2212 x 1659 pixels: 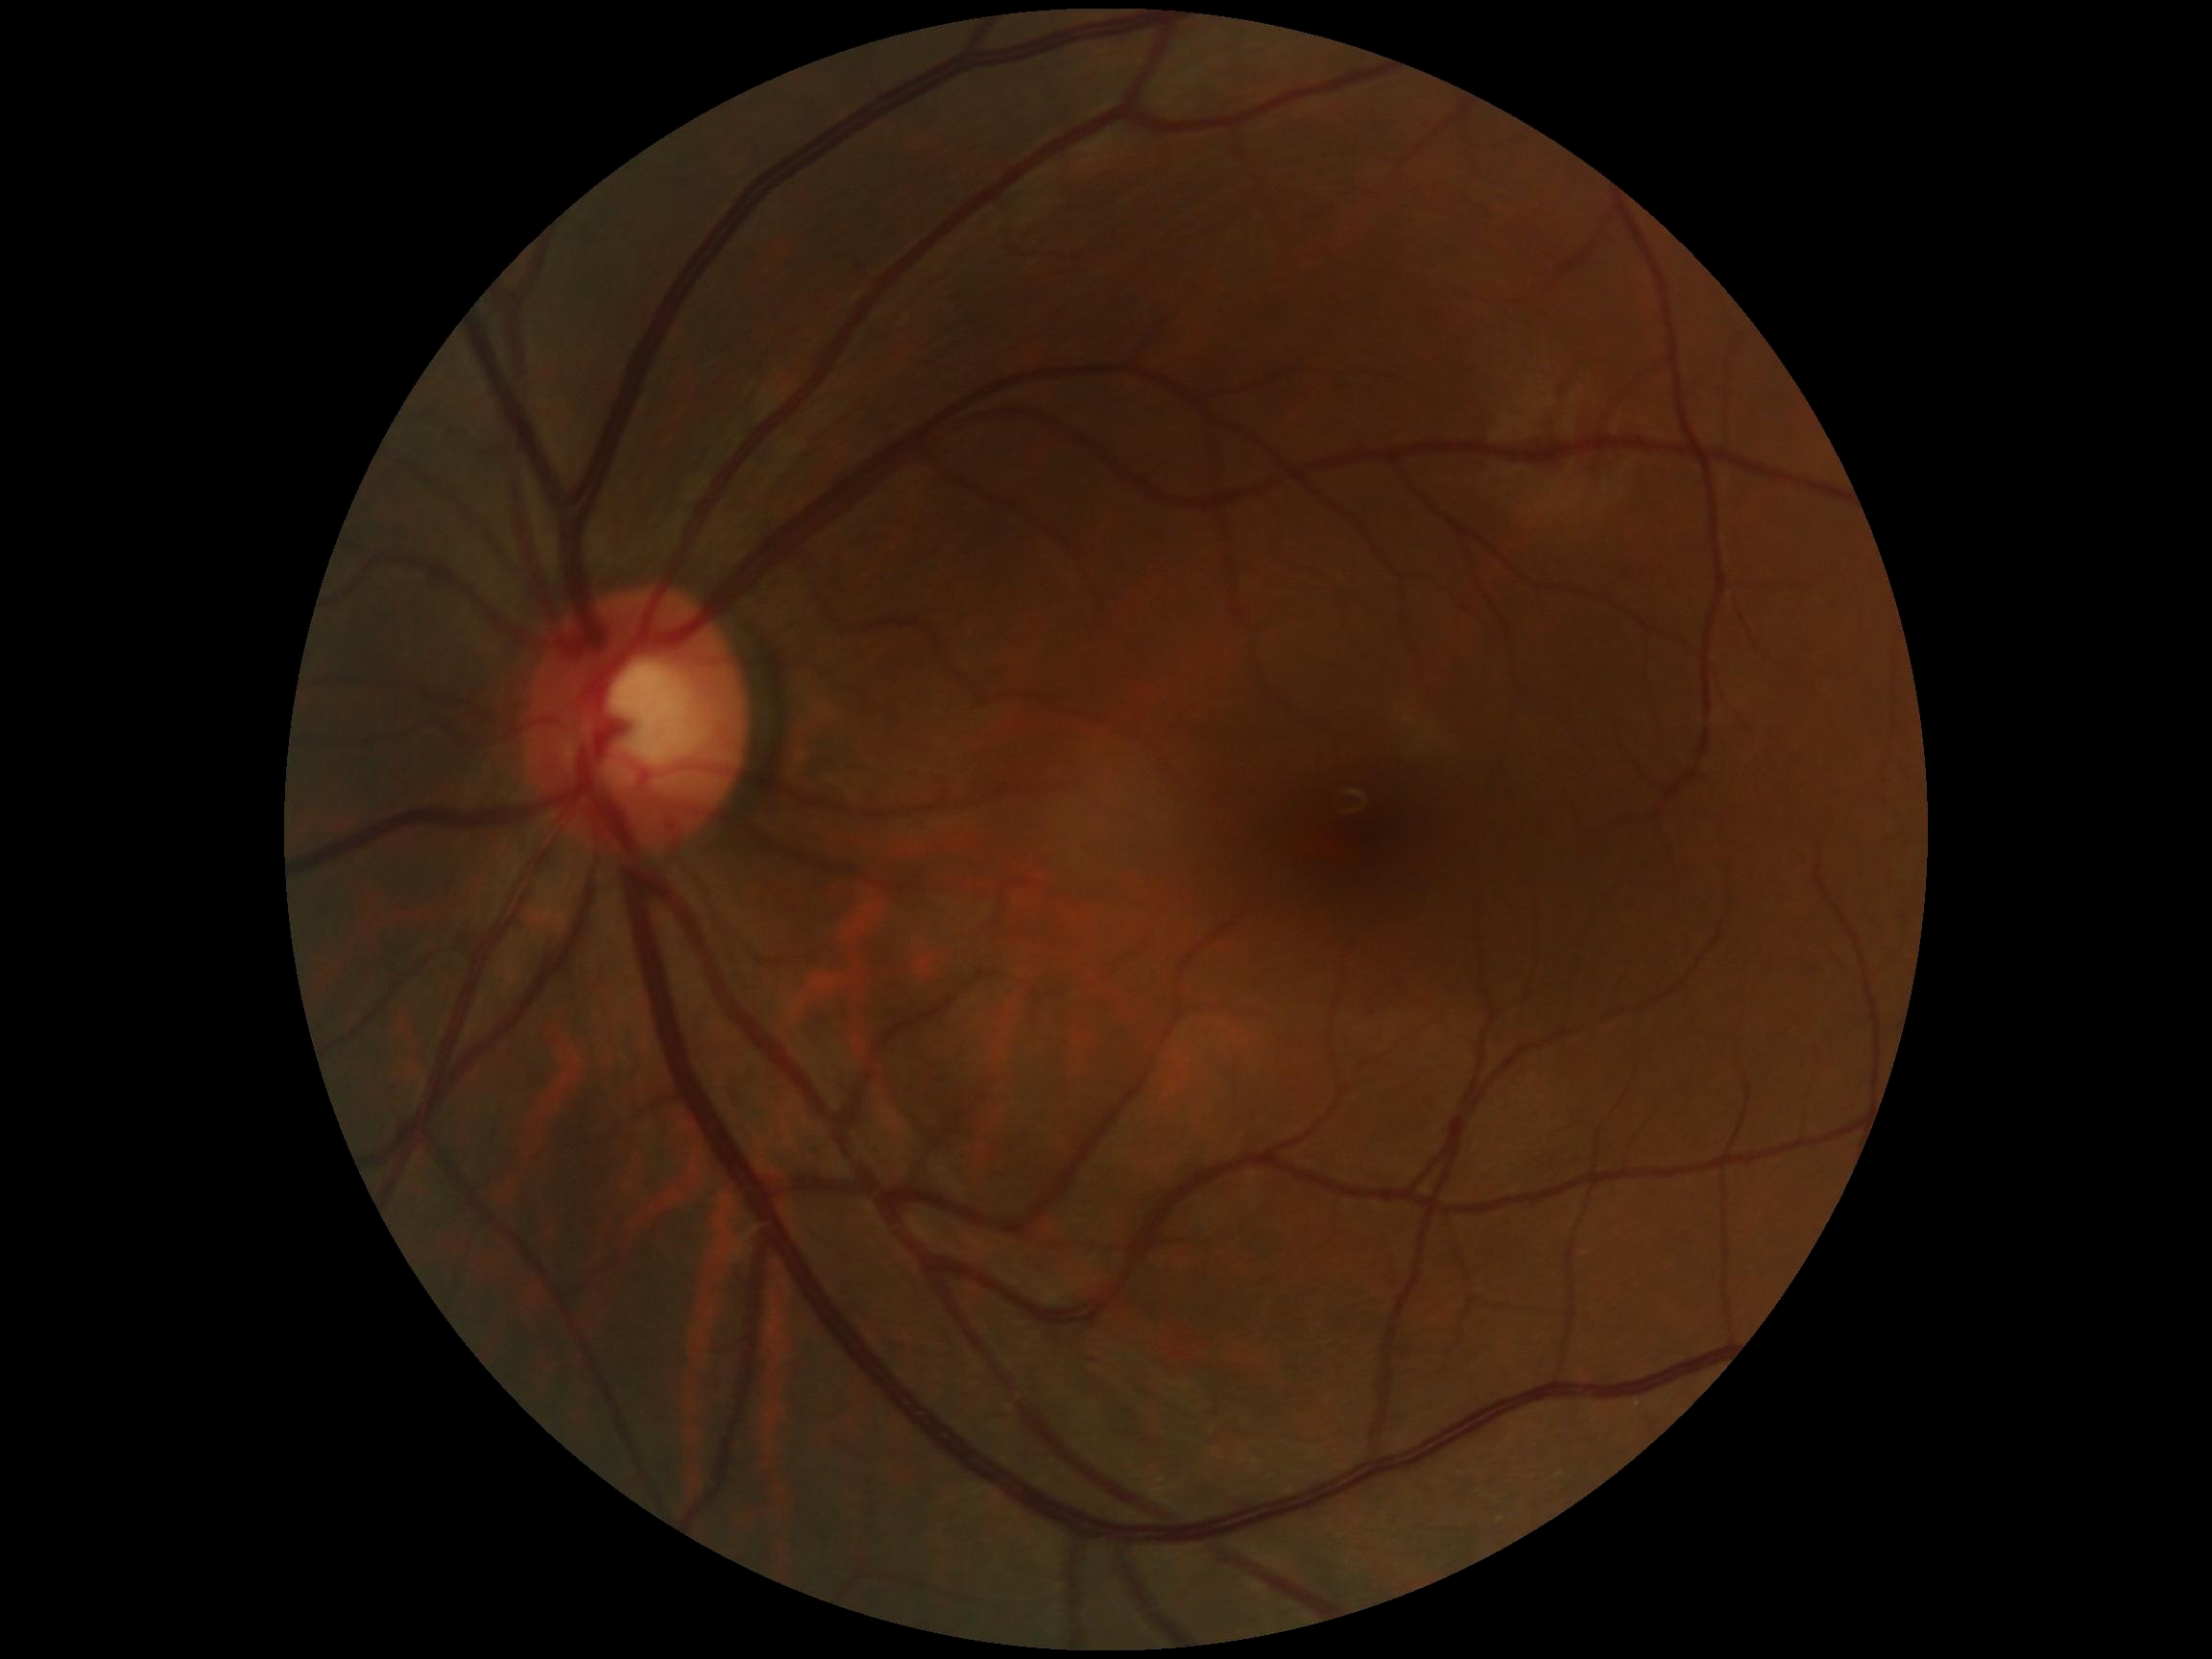 No apparent diabetic retinopathy. Diabetic retinopathy (DR) is grade 0 (no apparent retinopathy) — no visible signs of diabetic retinopathy.